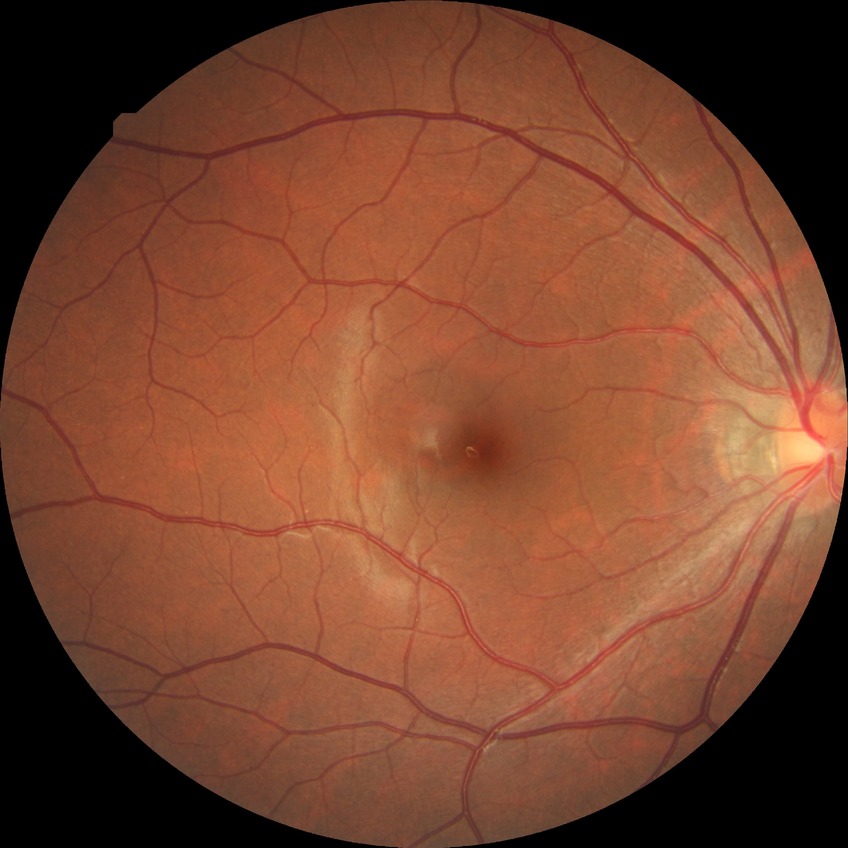
Diabetic retinopathy (DR): no diabetic retinopathy (NDR).